Retinal fundus photograph · 45° FOV: 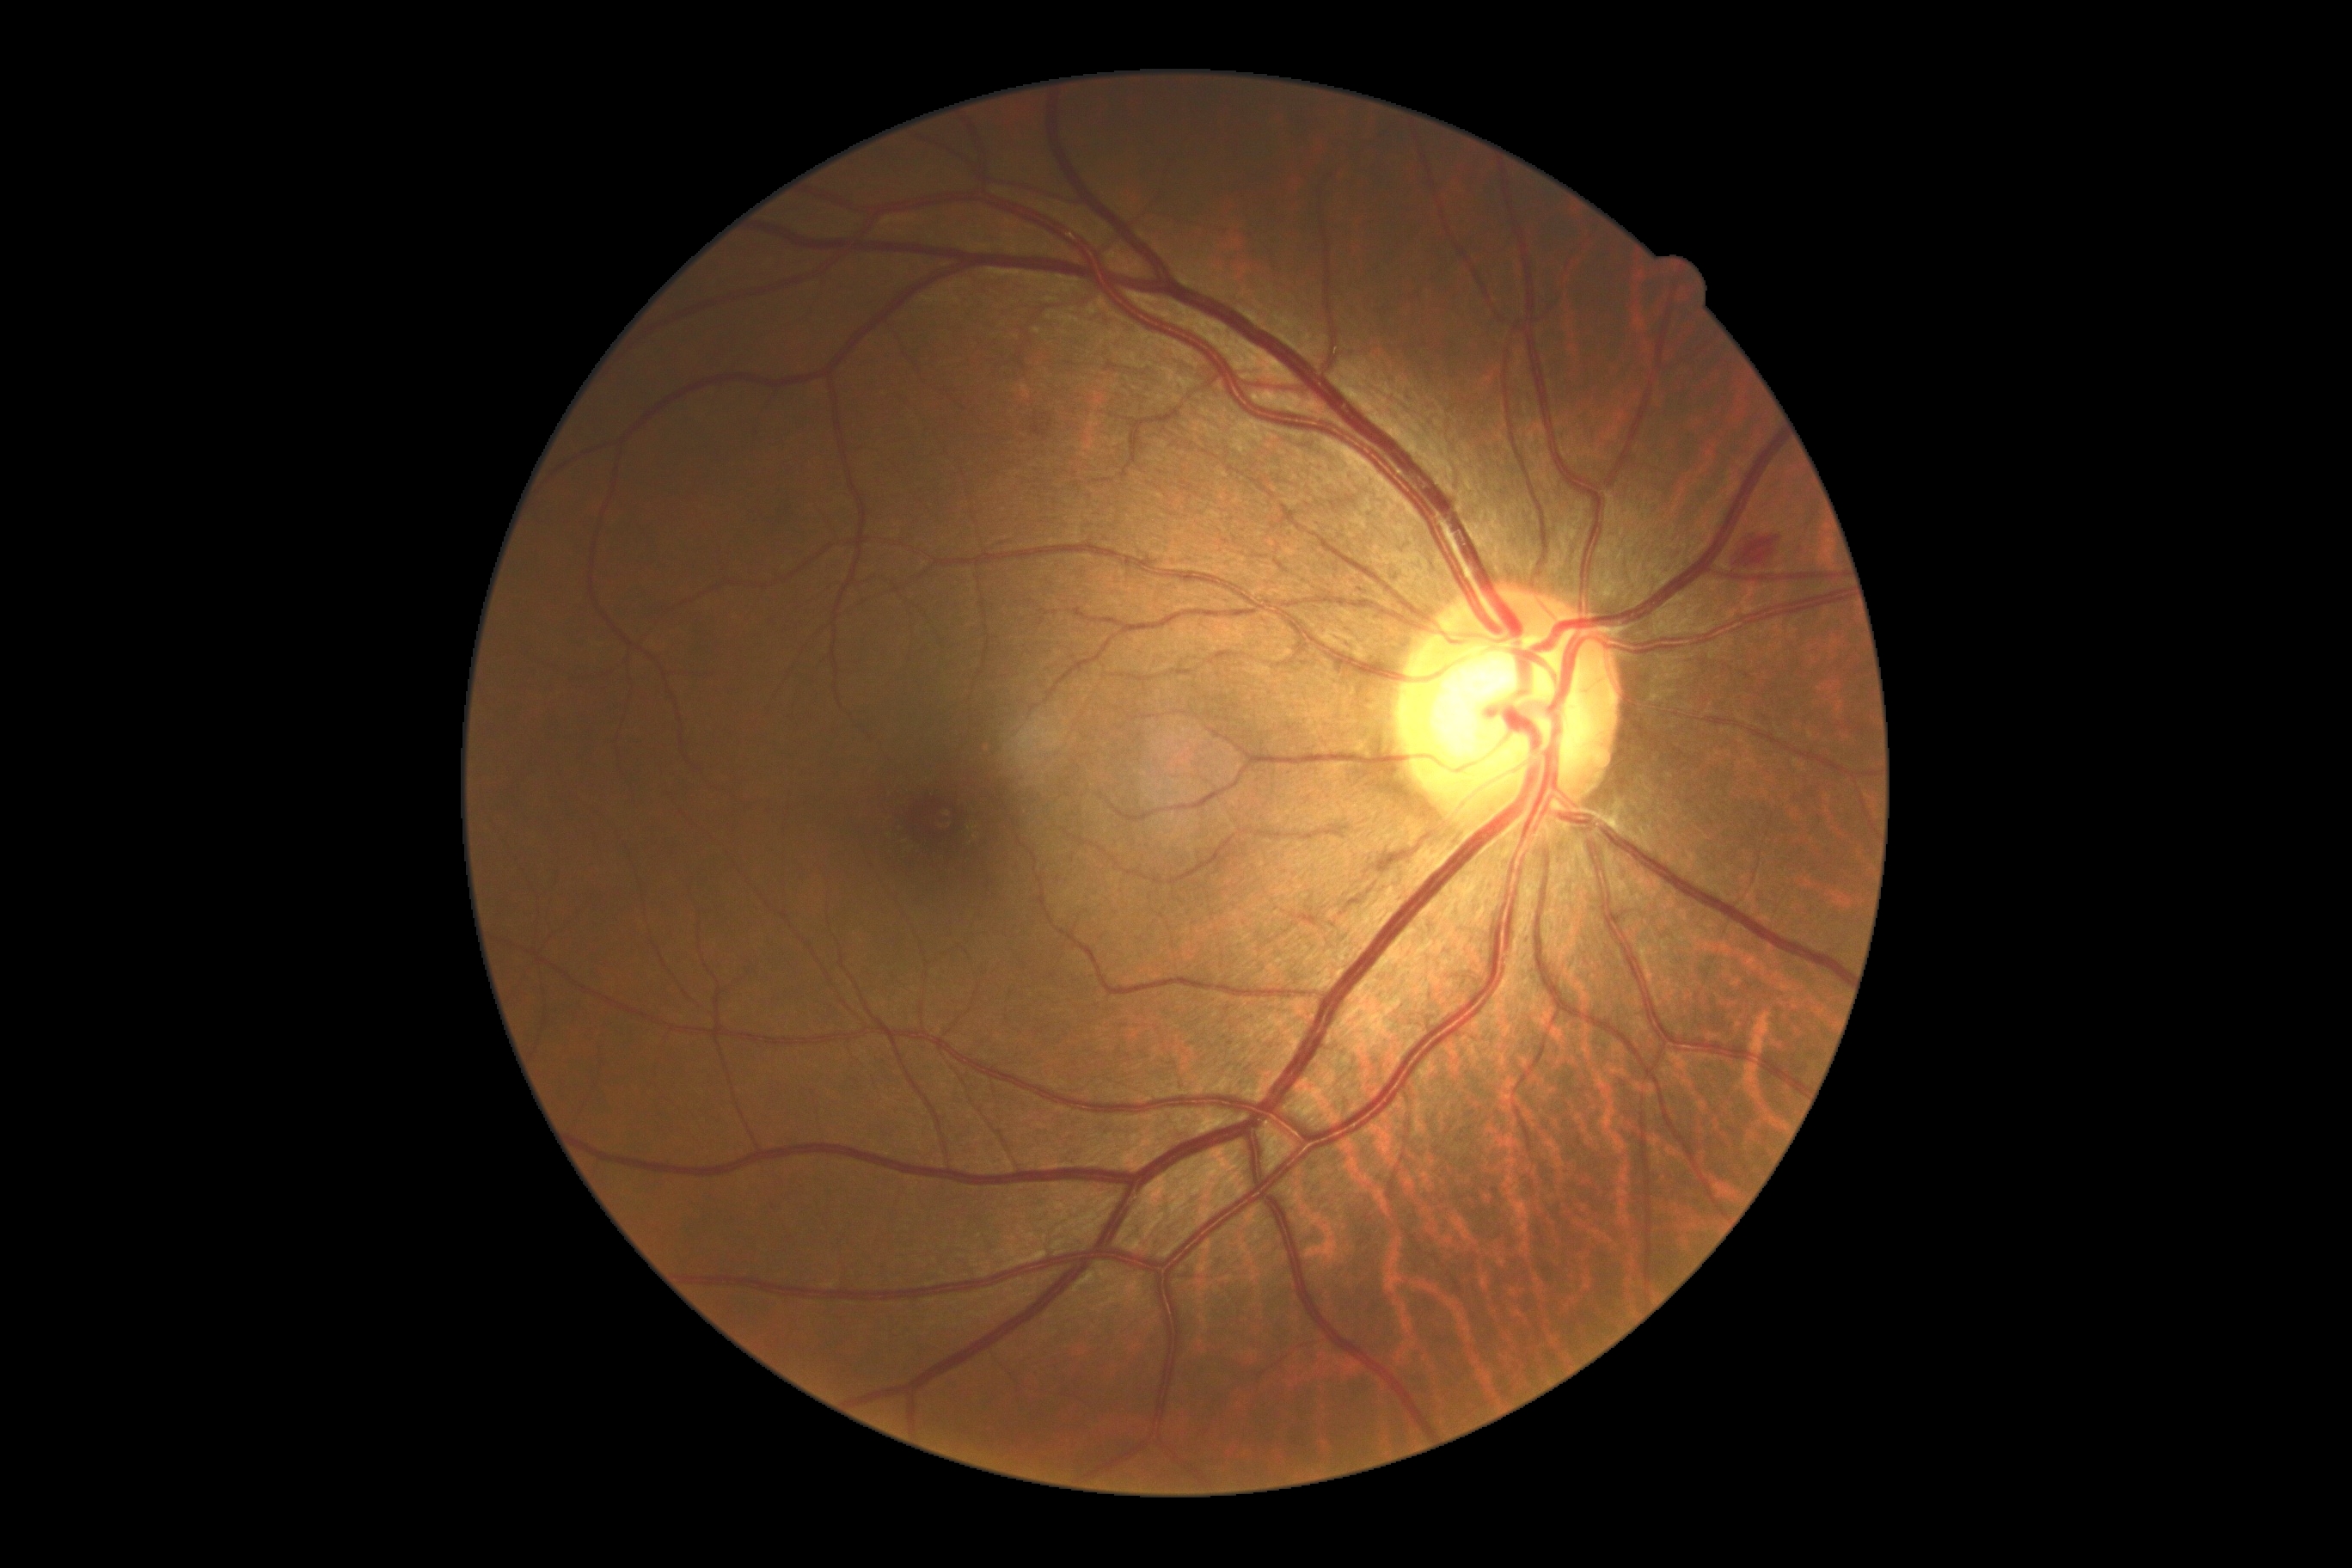 Diabetic retinopathy (DR) is 2/4. Disease class: non-proliferative diabetic retinopathy.